Nonmydriatic. Davis DR grading.
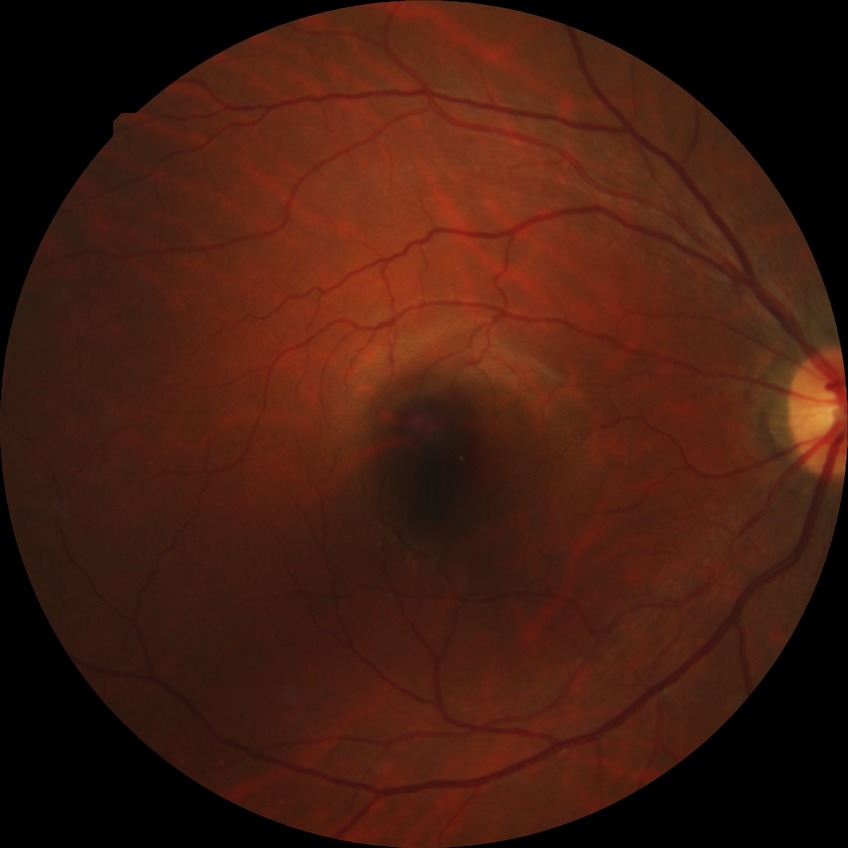 diabetic retinopathy (DR): simple diabetic retinopathy (SDR).